Diabetic retinopathy graded by the modified Davis classification. 848 by 848 pixels. Retinal fundus photograph
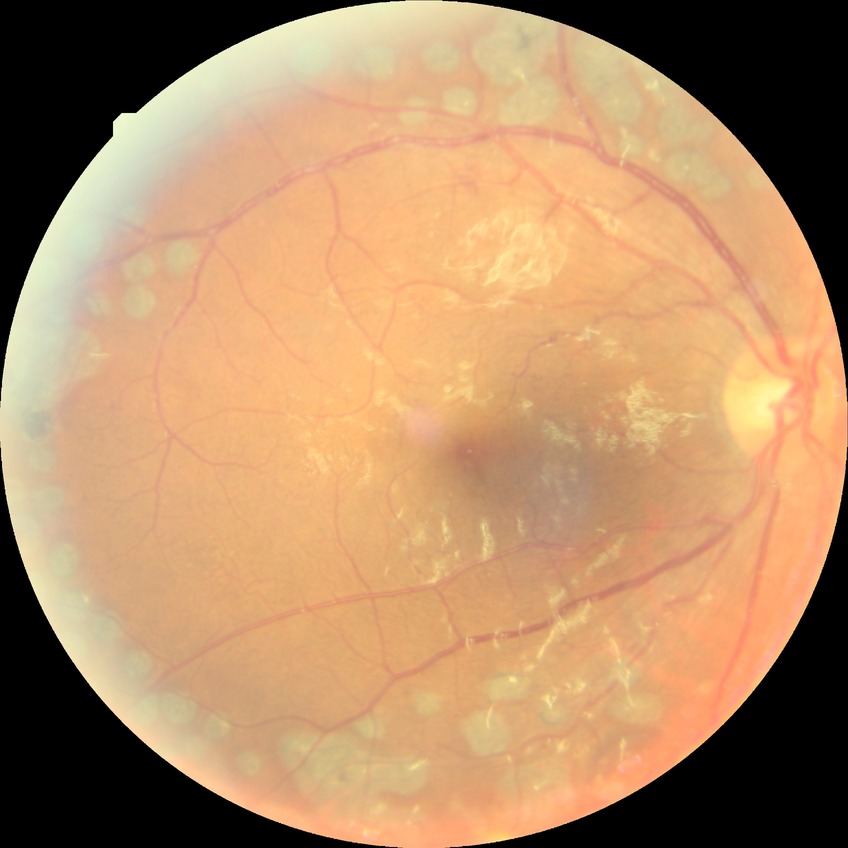

Findings:
- diabetic retinopathy (DR): PDR (proliferative diabetic retinopathy)